45° FOV. Davis DR grading. Fundus photo: 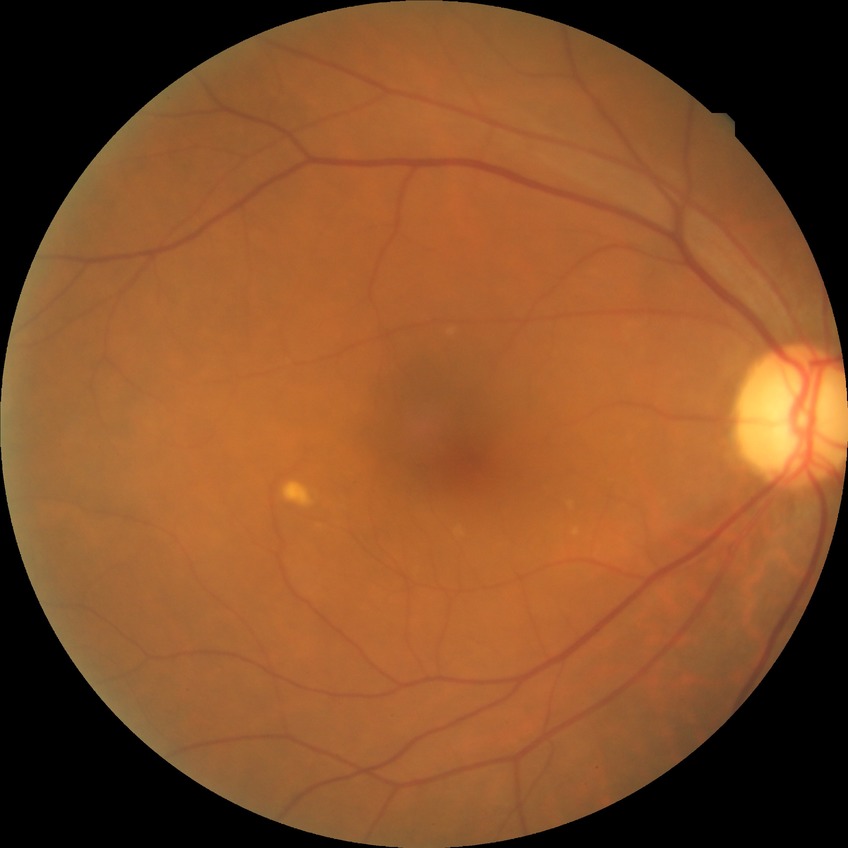
Diabetic retinopathy (DR): no diabetic retinopathy (NDR).